Without pupil dilation · NIDEK AFC-230 — 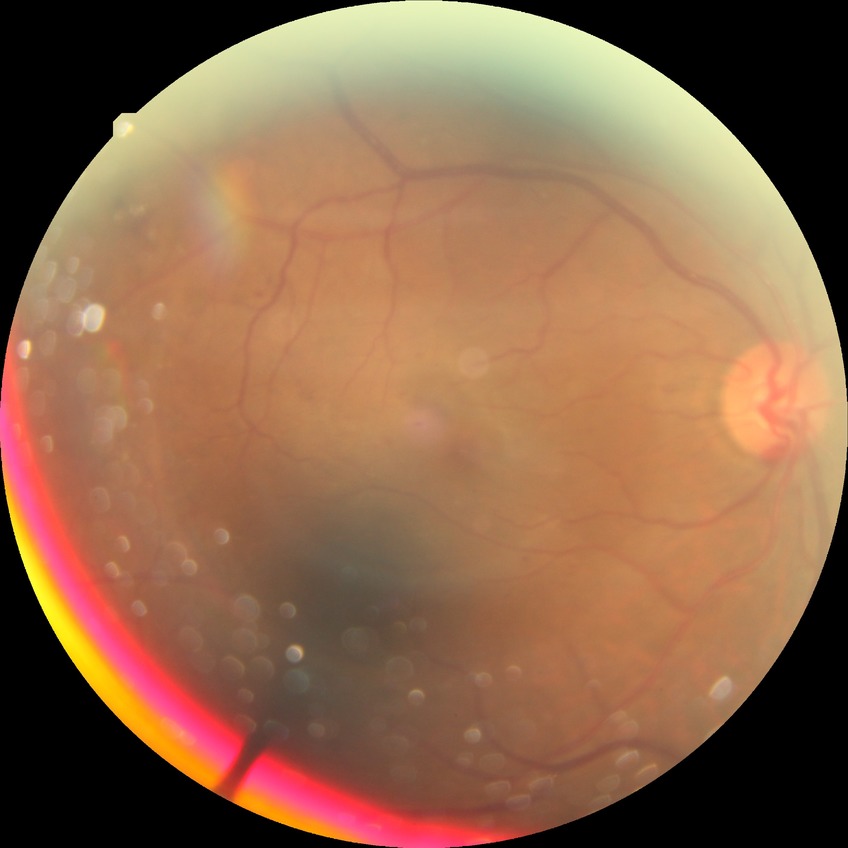
Diabetic retinopathy (DR) is PDR (proliferative diabetic retinopathy).